45° FOV · 2212 by 1659 pixels · color fundus image.
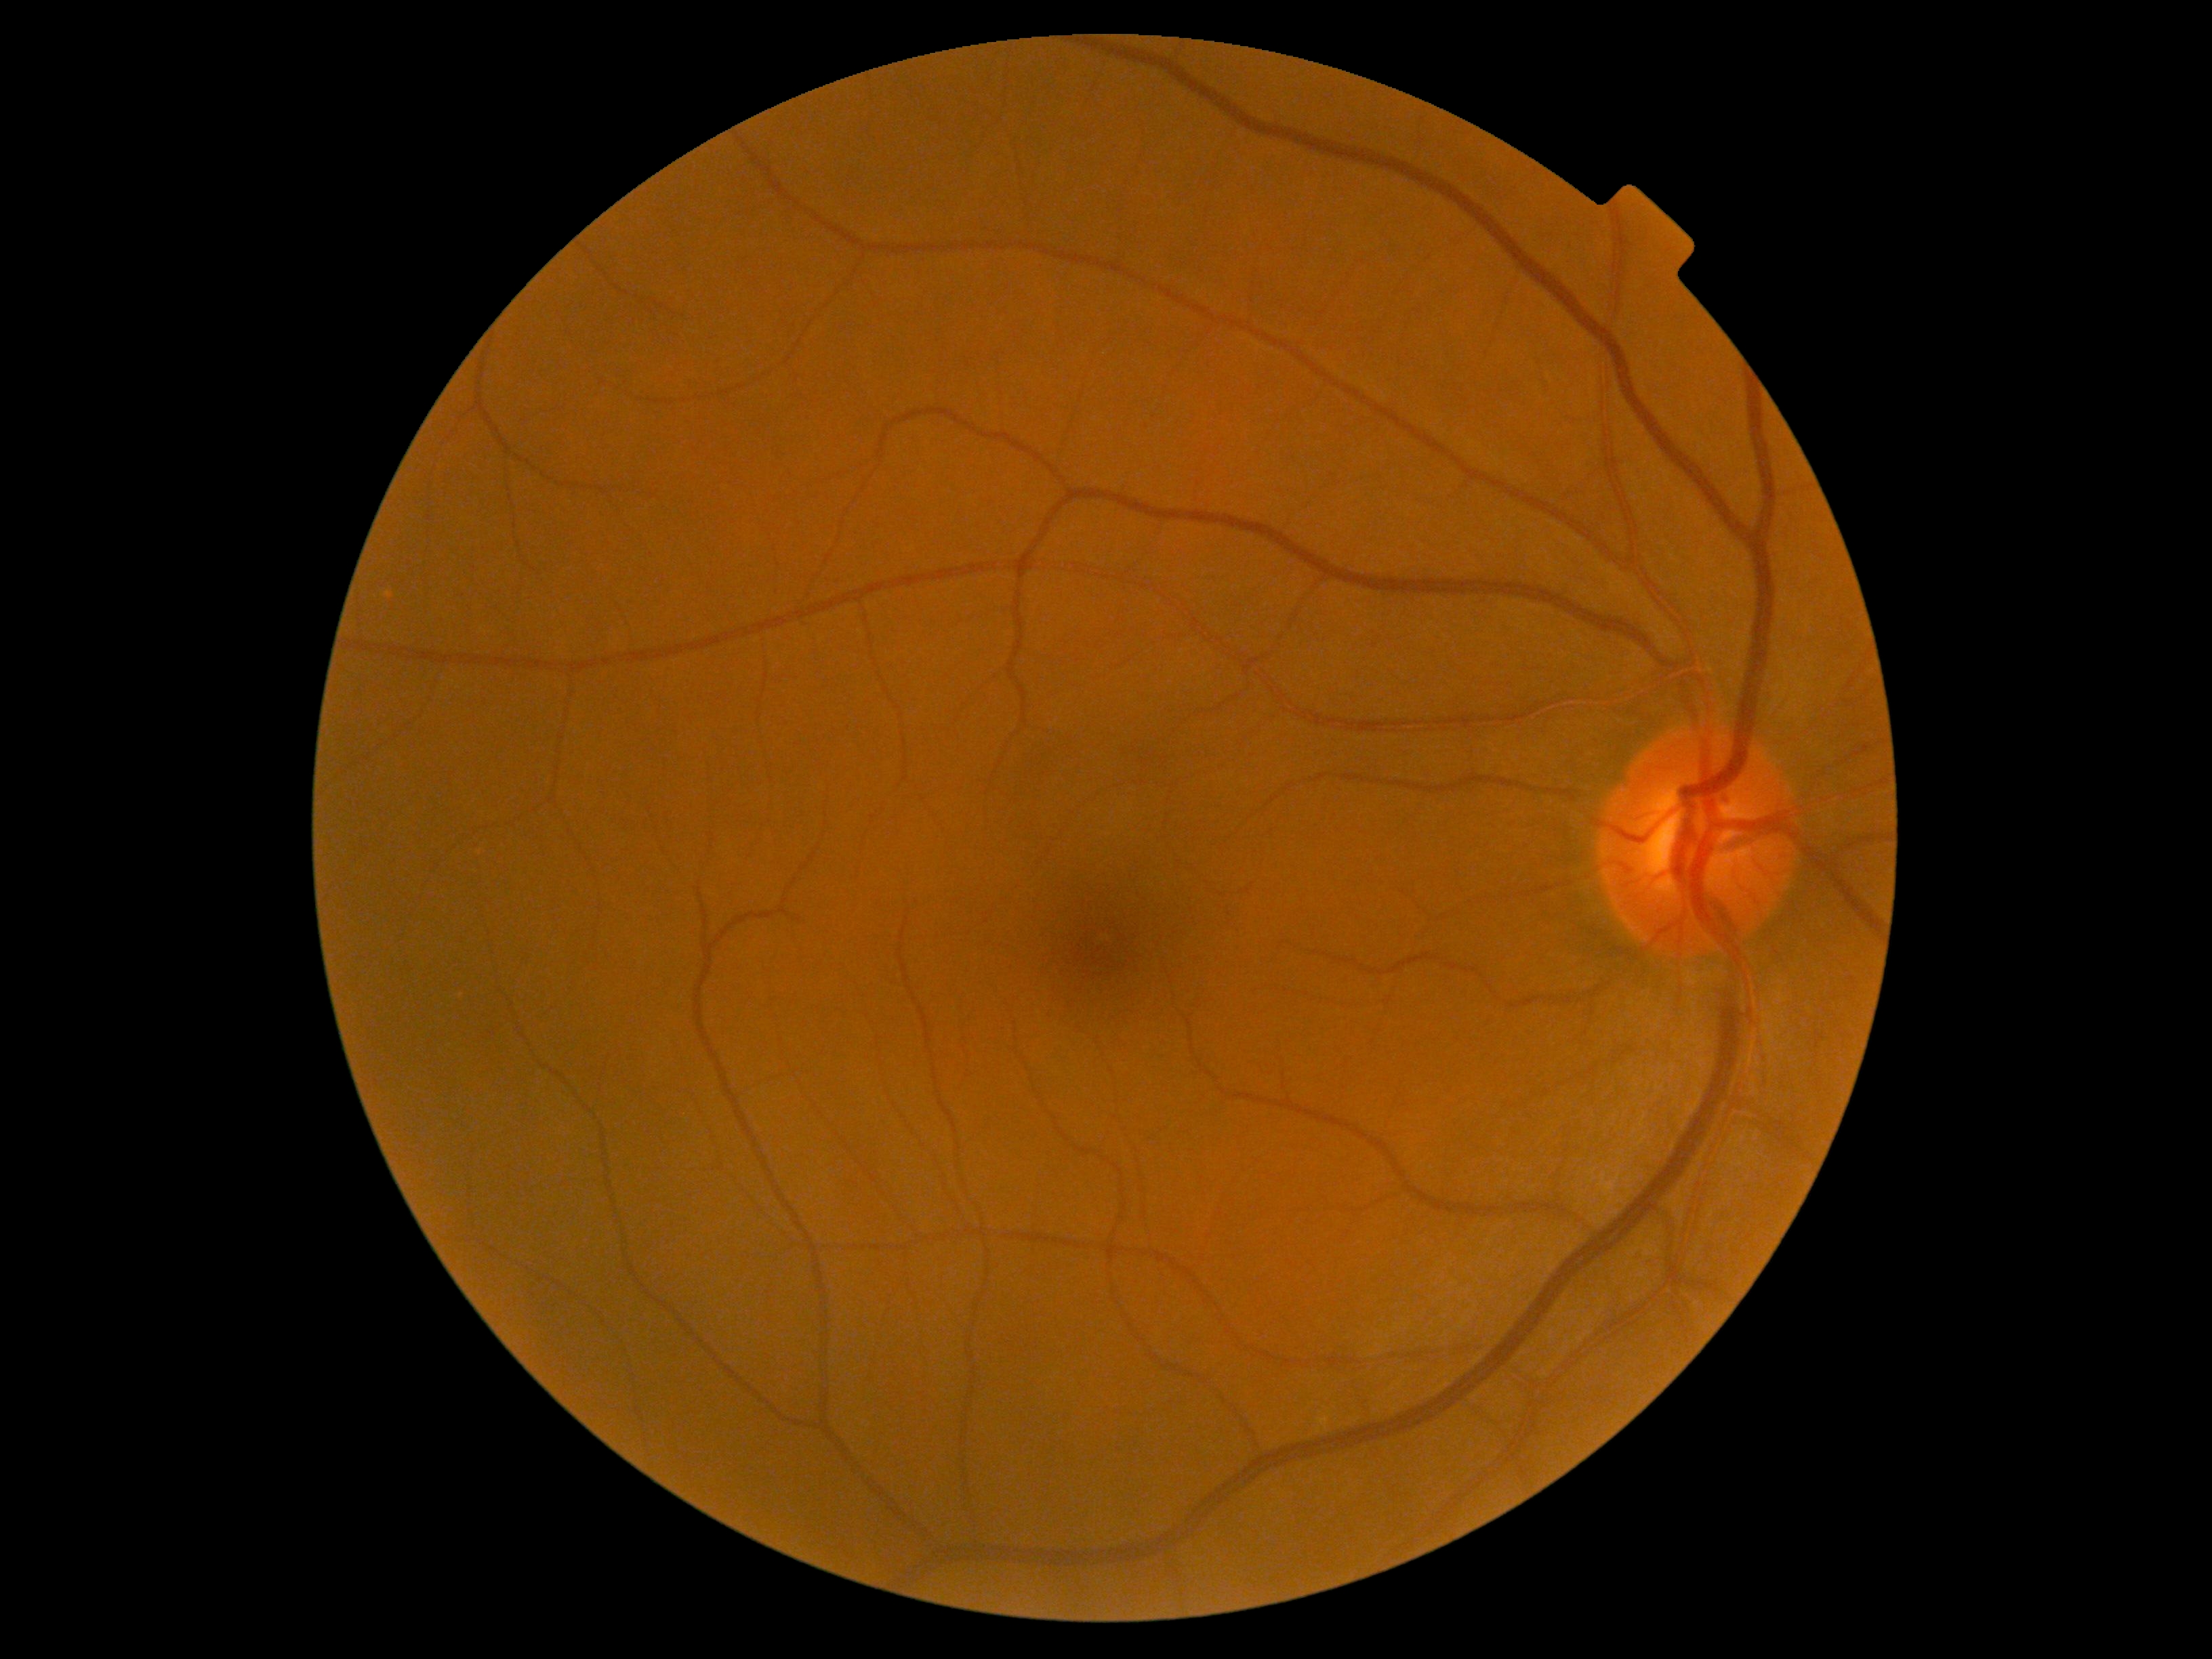
No DR findings. Diabetic retinopathy (DR): grade 0 (no apparent retinopathy).